Image size 1659x2212.
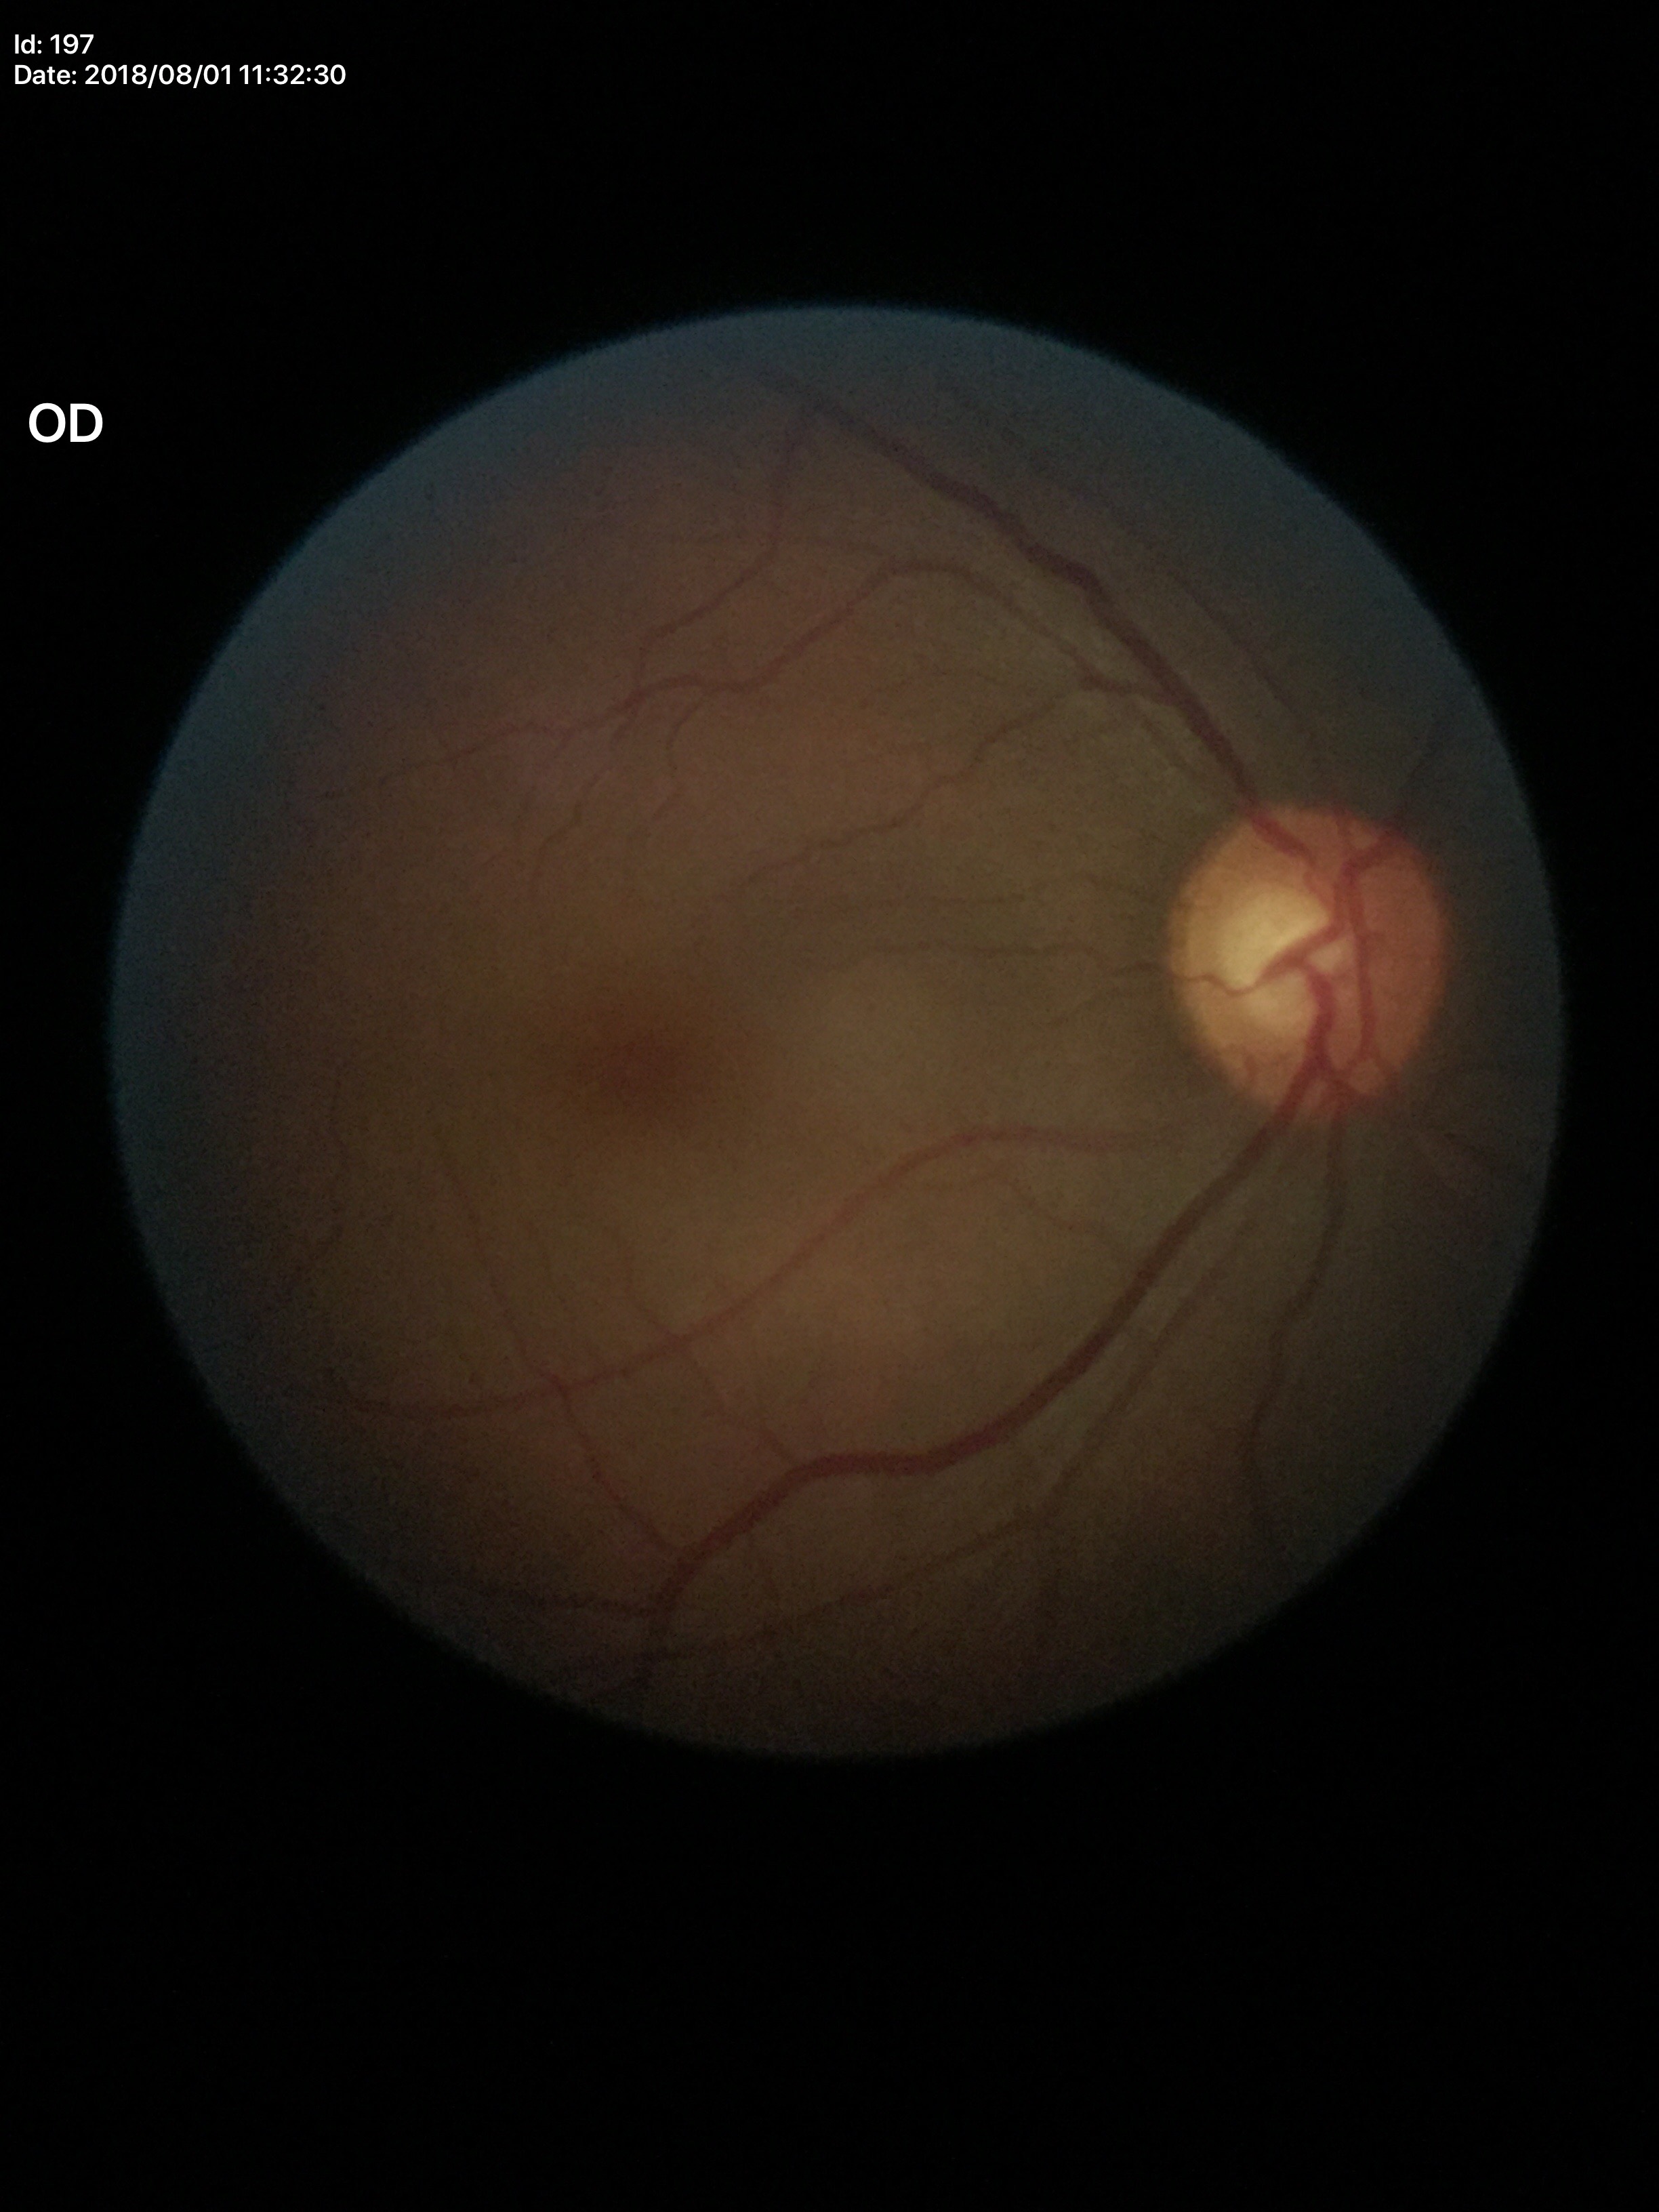 hcdr: 0.63
vcdr: 0.60
glaucoma_decision: suspicious findings (4/5 graders called glaucoma suspect)